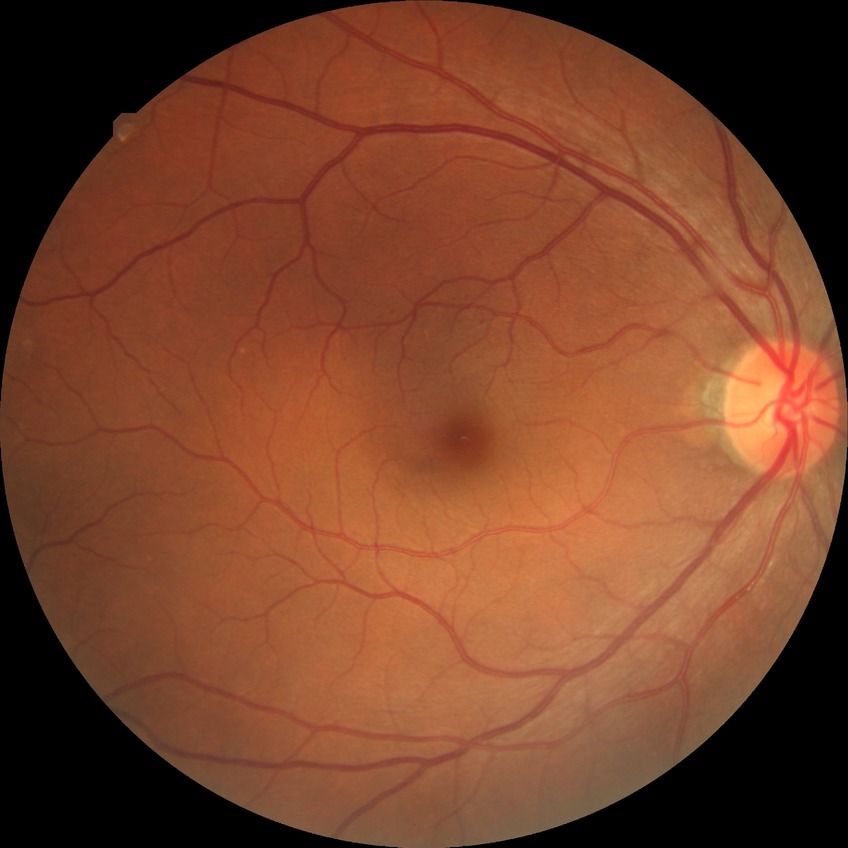
Diabetic retinopathy stage: no diabetic retinopathy.